Image size 2212x1659.
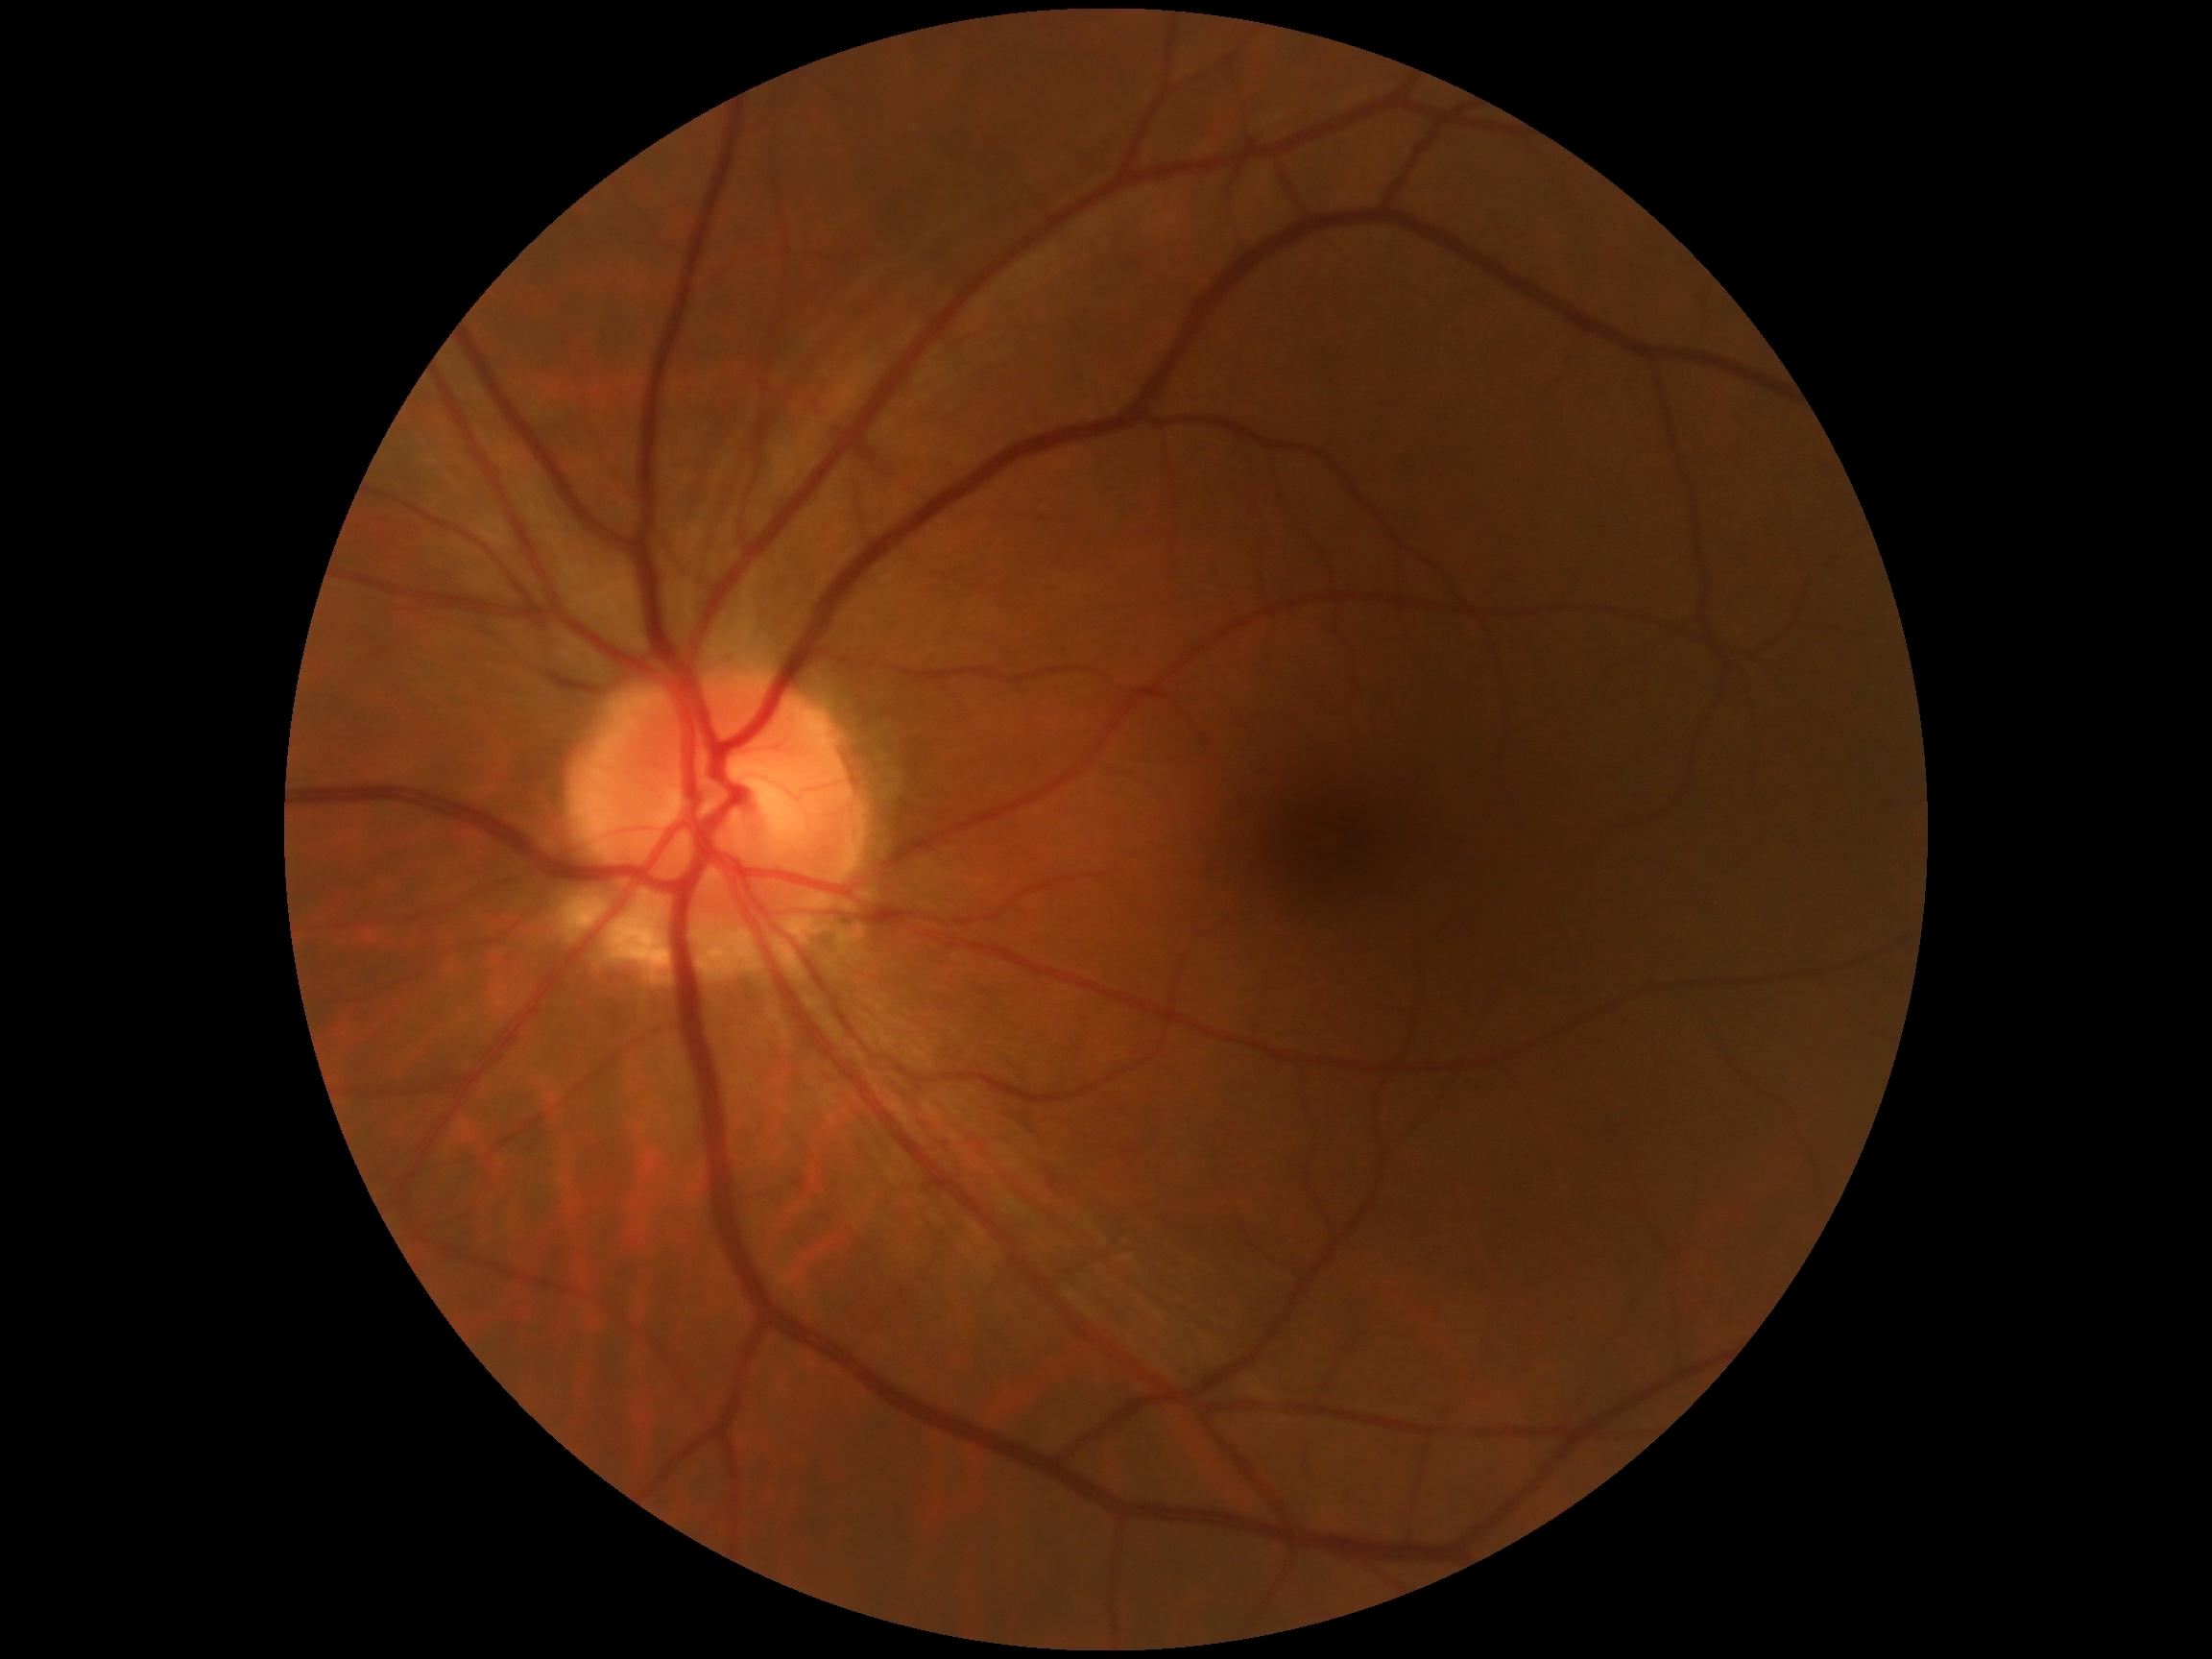
DR severity: grade 0 (no apparent retinopathy). No signs of diabetic retinopathy.